Graded on the modified Davis scale — 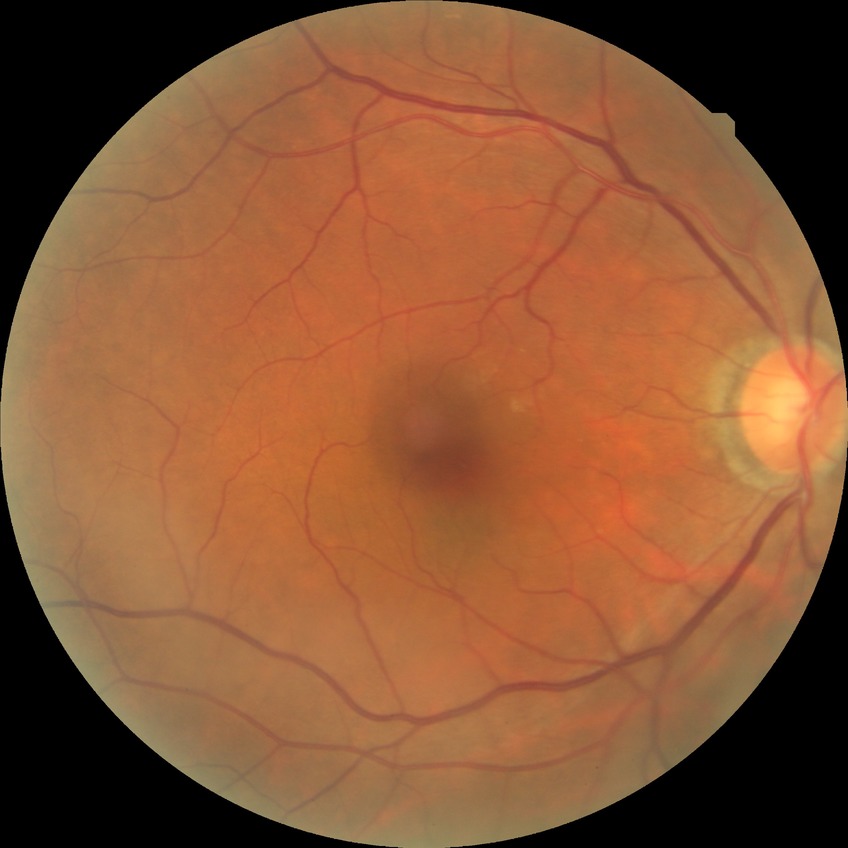
Retinopathy grade is no diabetic retinopathy.